2346 by 1568 pixels.
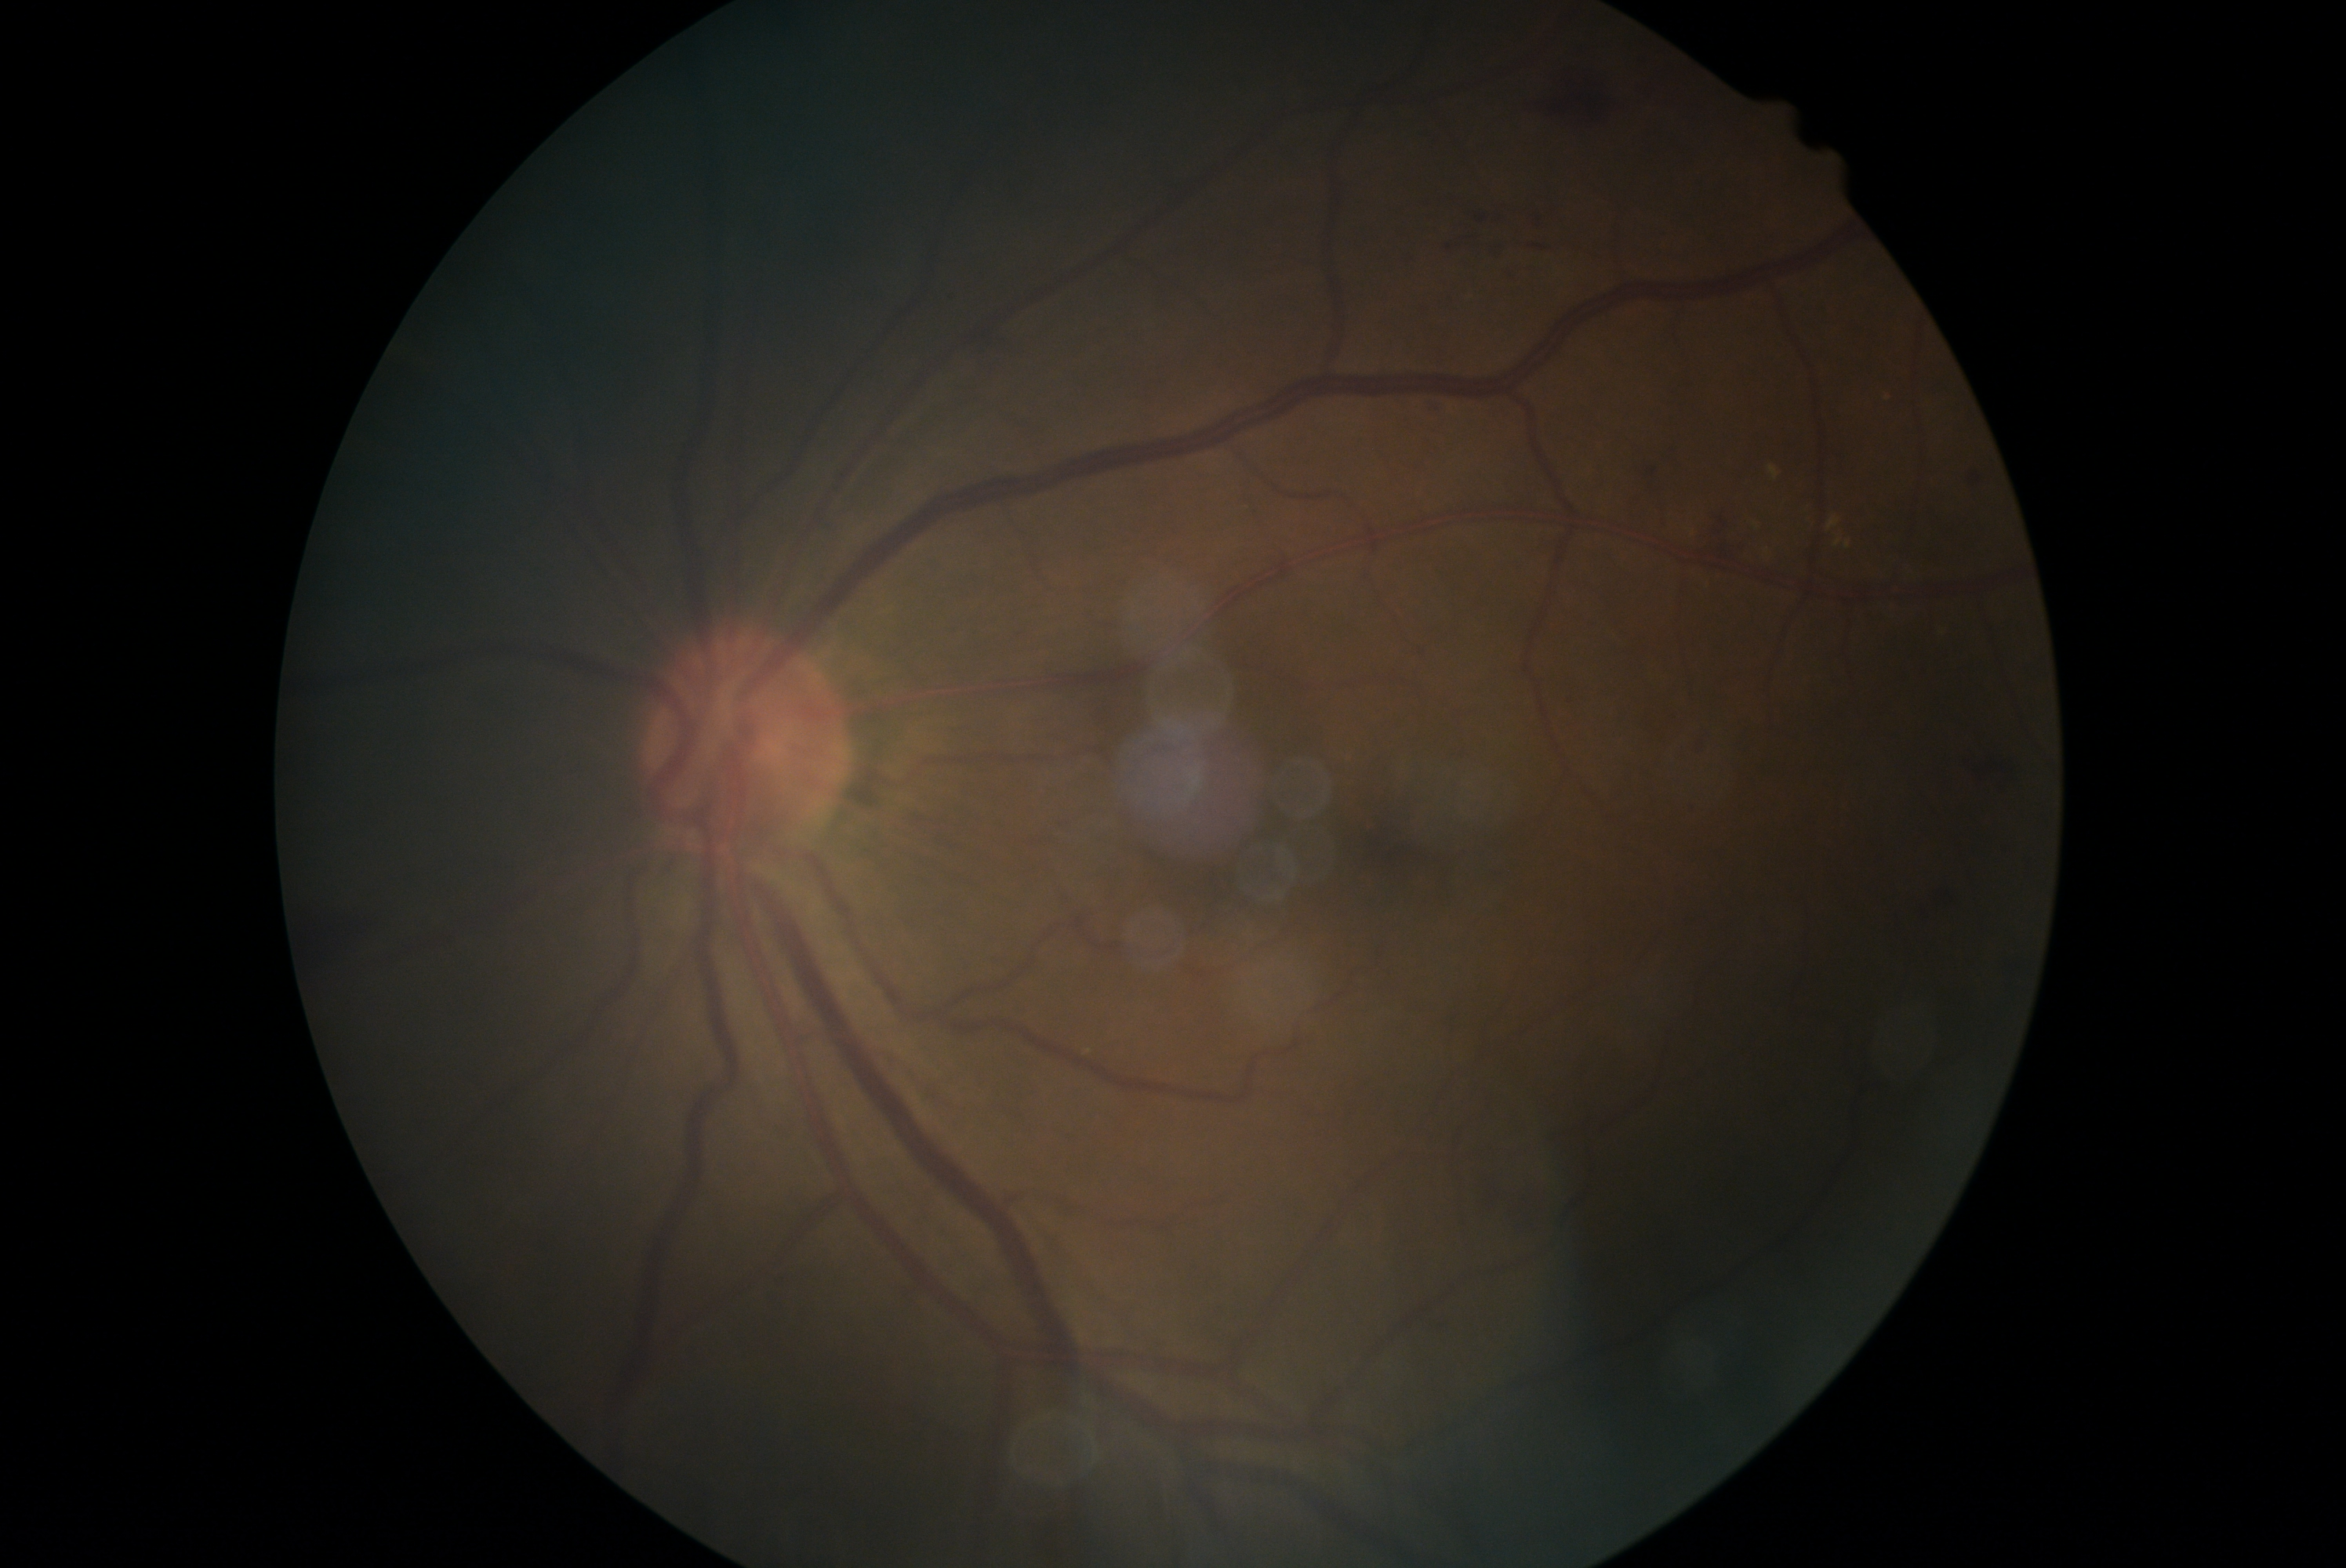
Diabetic retinopathy (DR) is 2.